FOV: 50 degrees · captured after pupil dilation · 2228 x 1652 pixels: 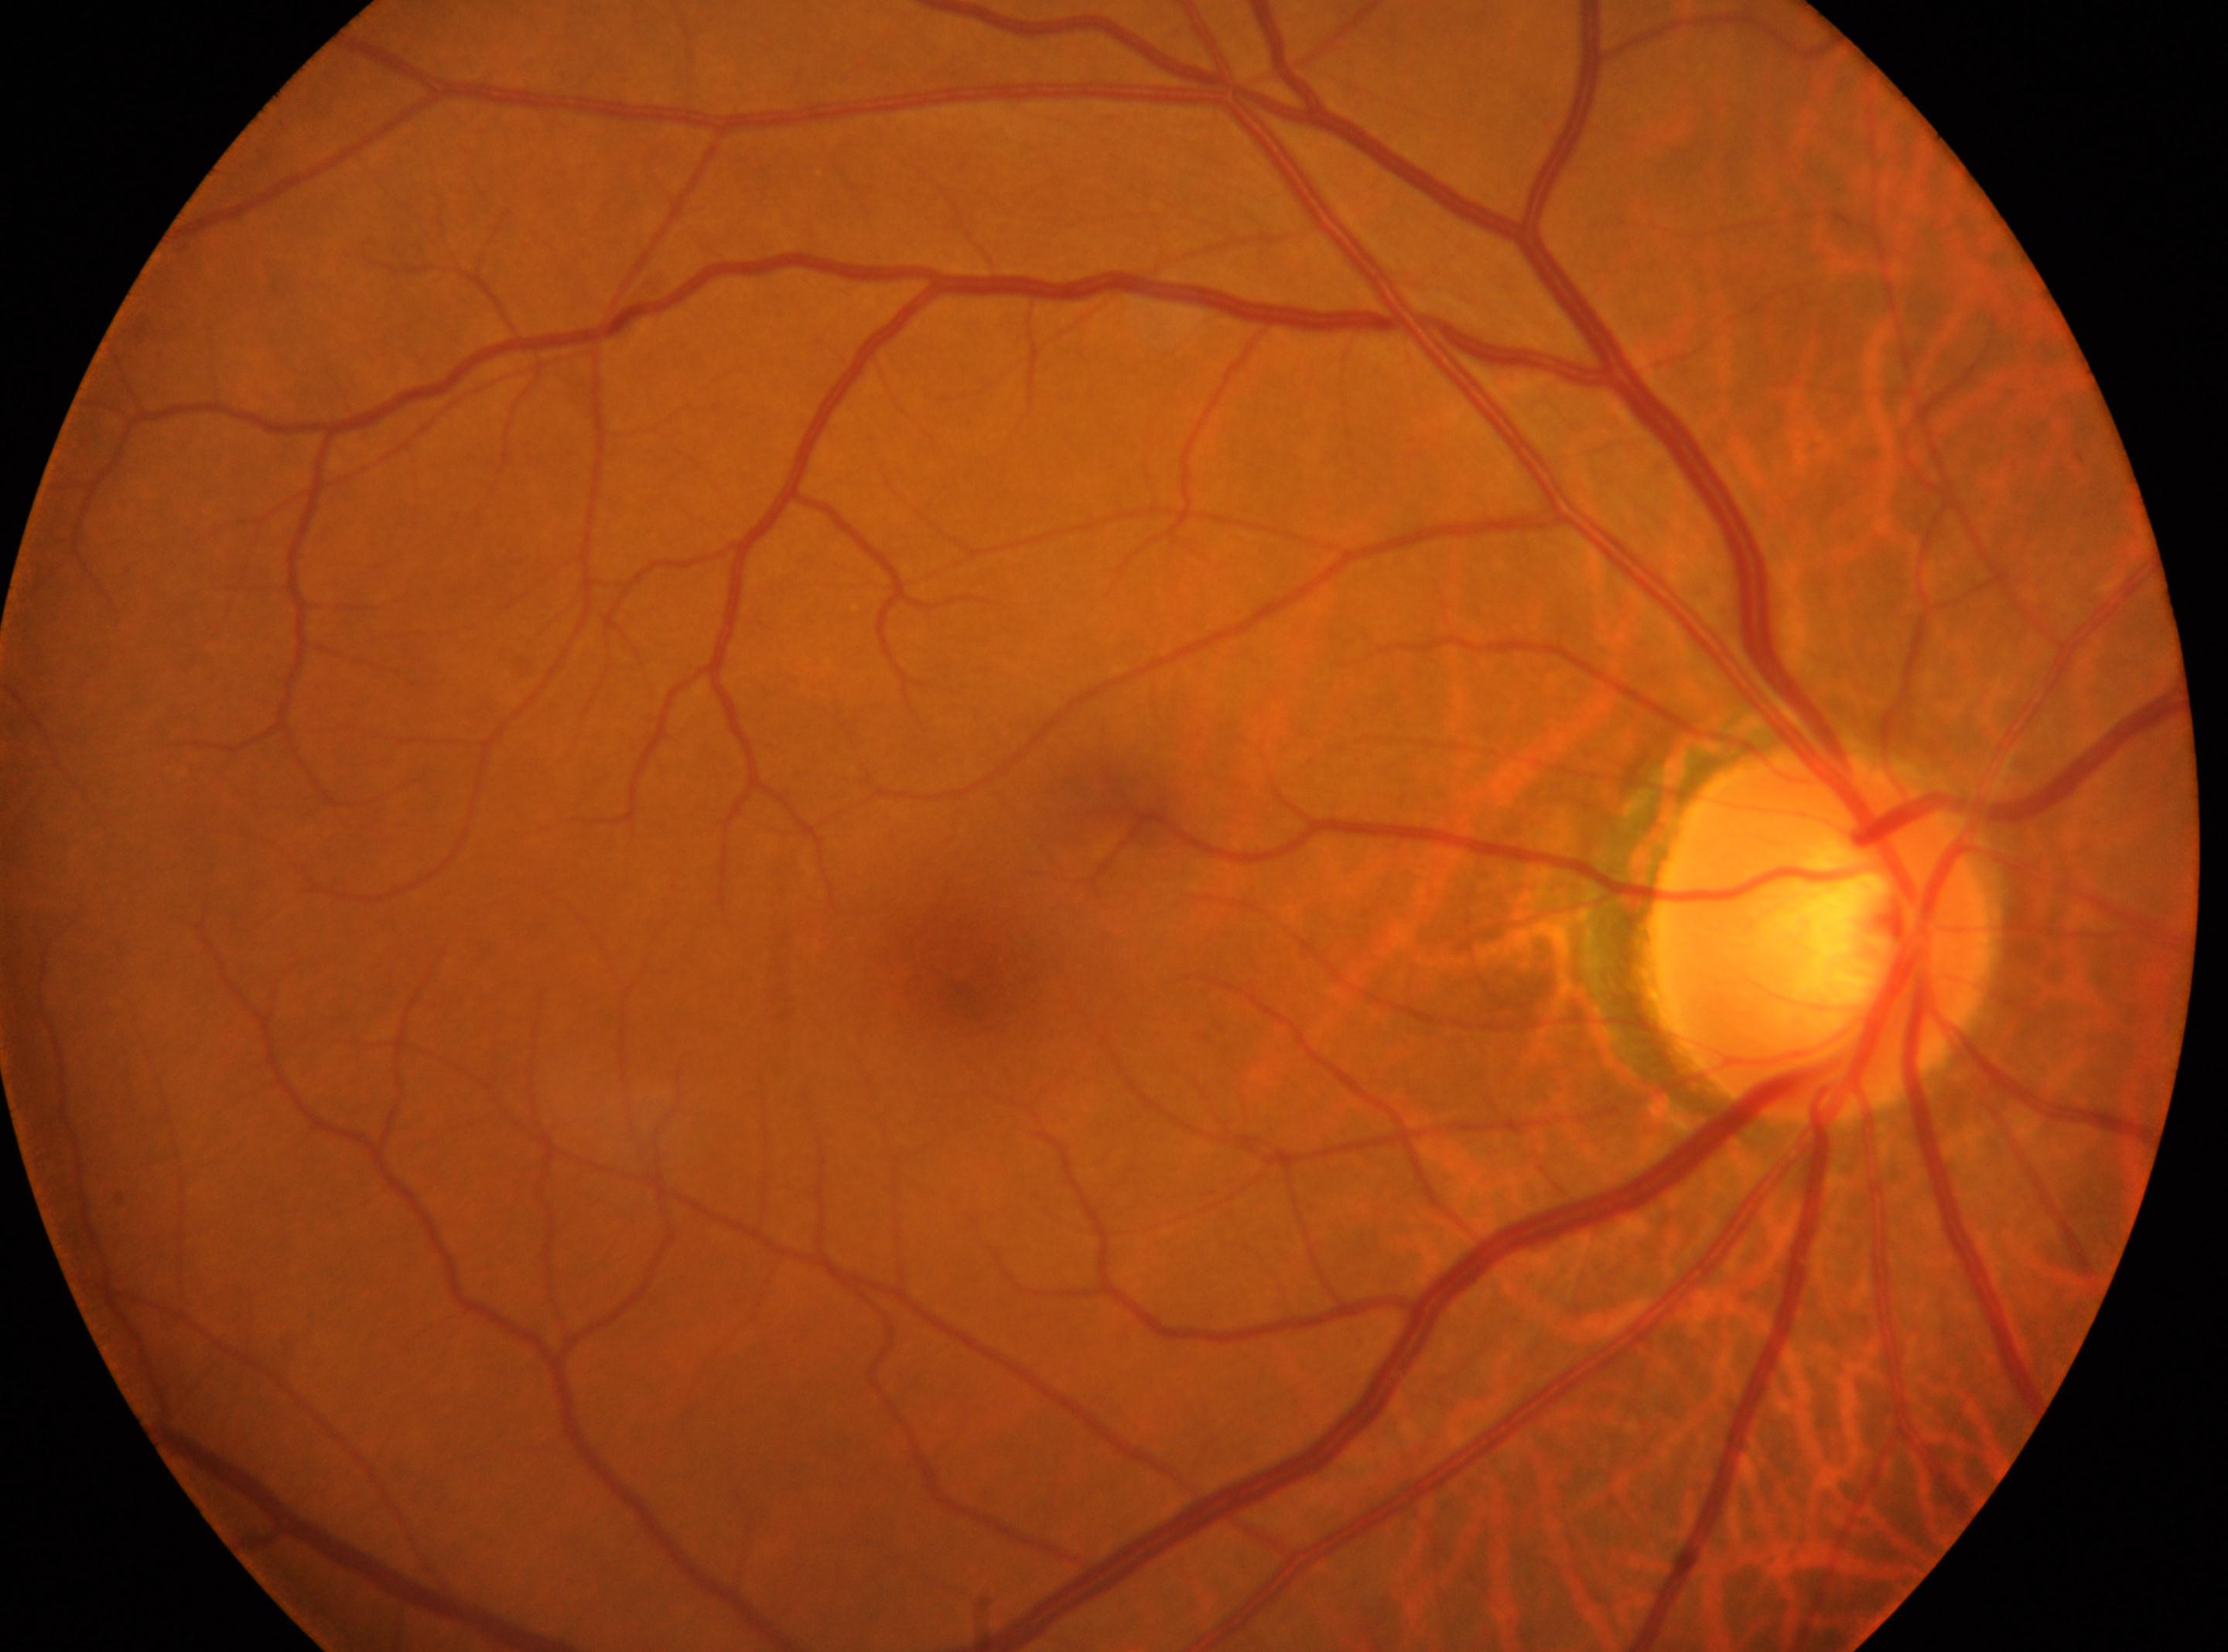
right | fovea center=961px, 971px | diabetic retinopathy grade=0 — no visible signs of diabetic retinopathy | optic disk=1820px, 933px.